848x848px, modified Davis grading.
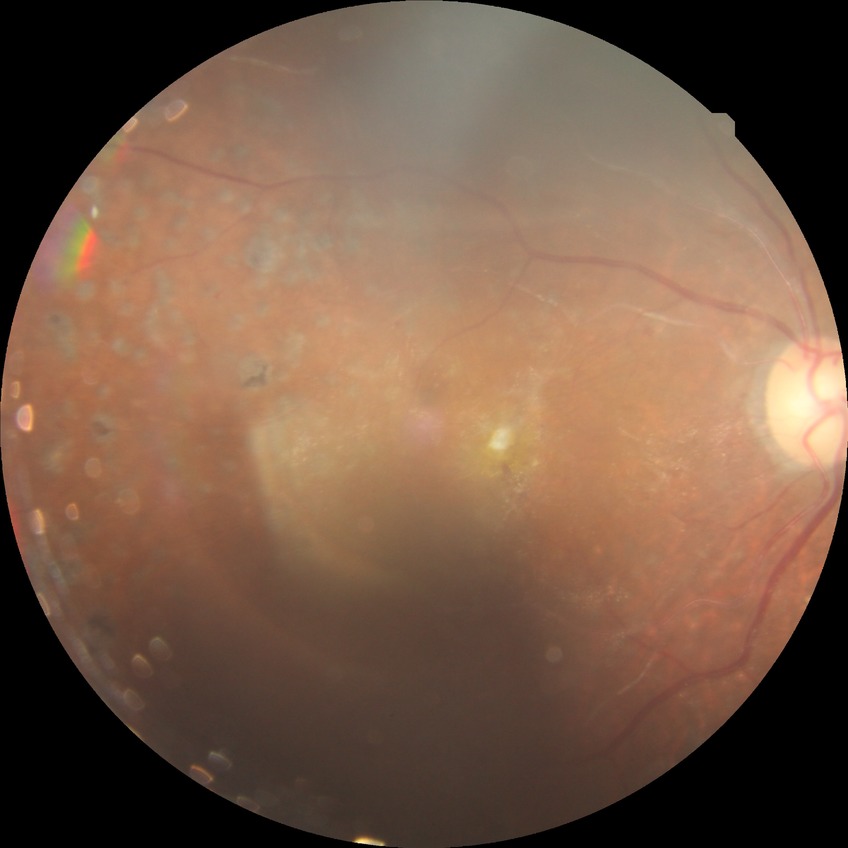 Diabetic retinopathy (DR) is proliferative diabetic retinopathy (PDR).